Captured with the Natus RetCam Envision (130° field of view). Wide-field fundus photograph of an infant:
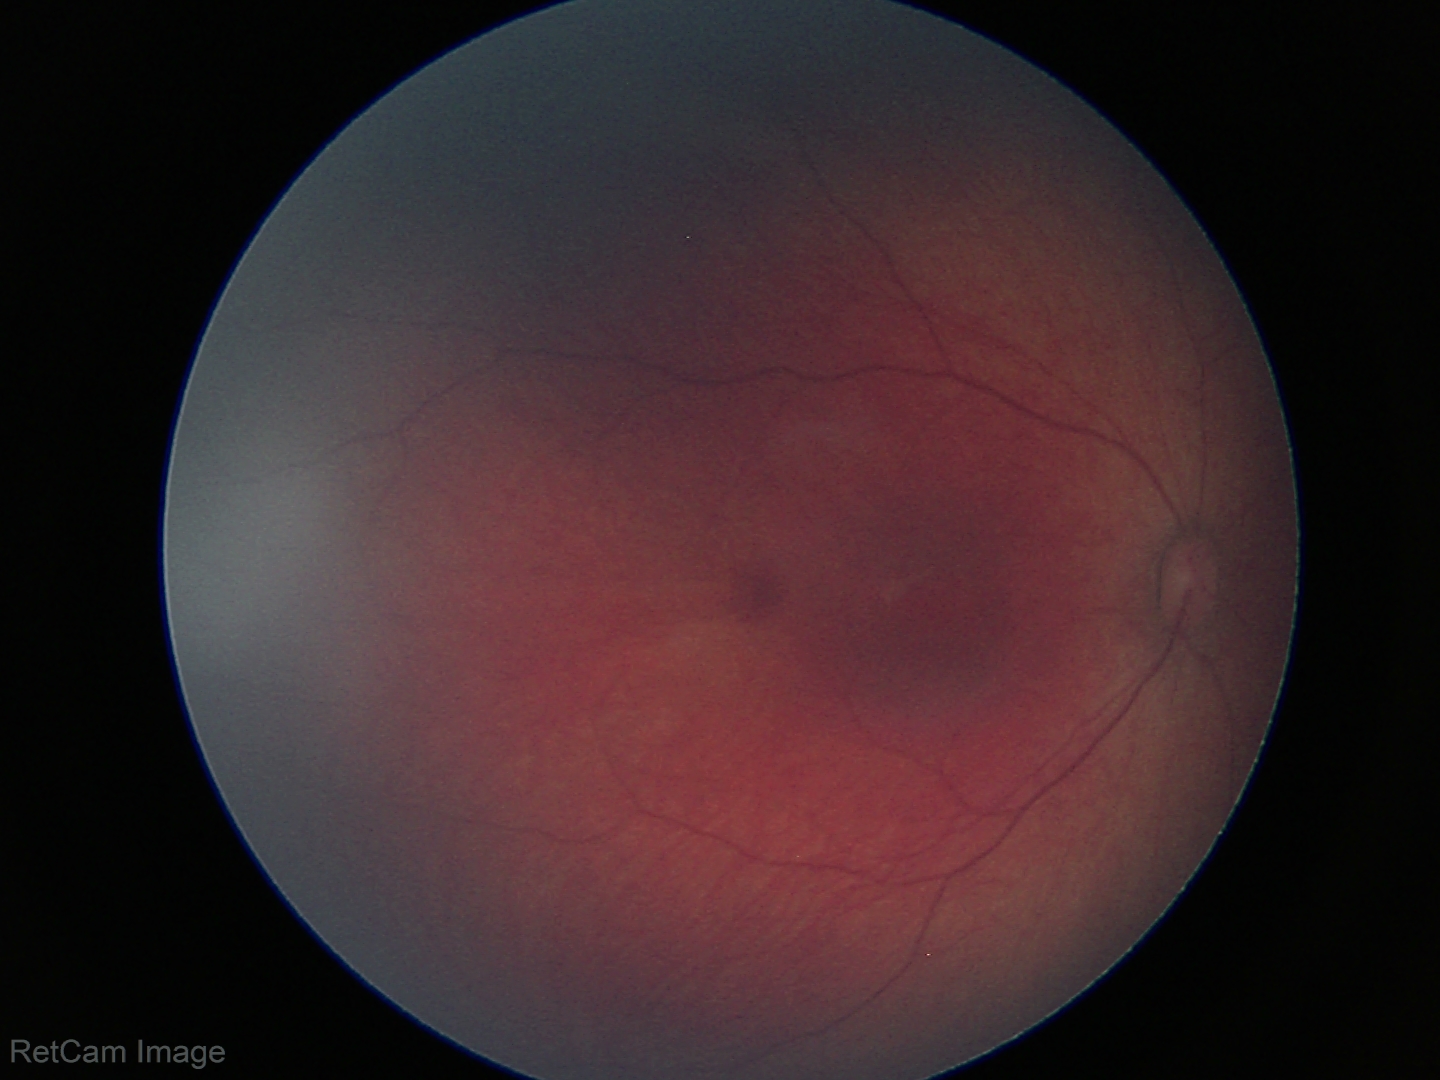

Impression = physiological.